2228 by 1652 pixels · central posterior field:
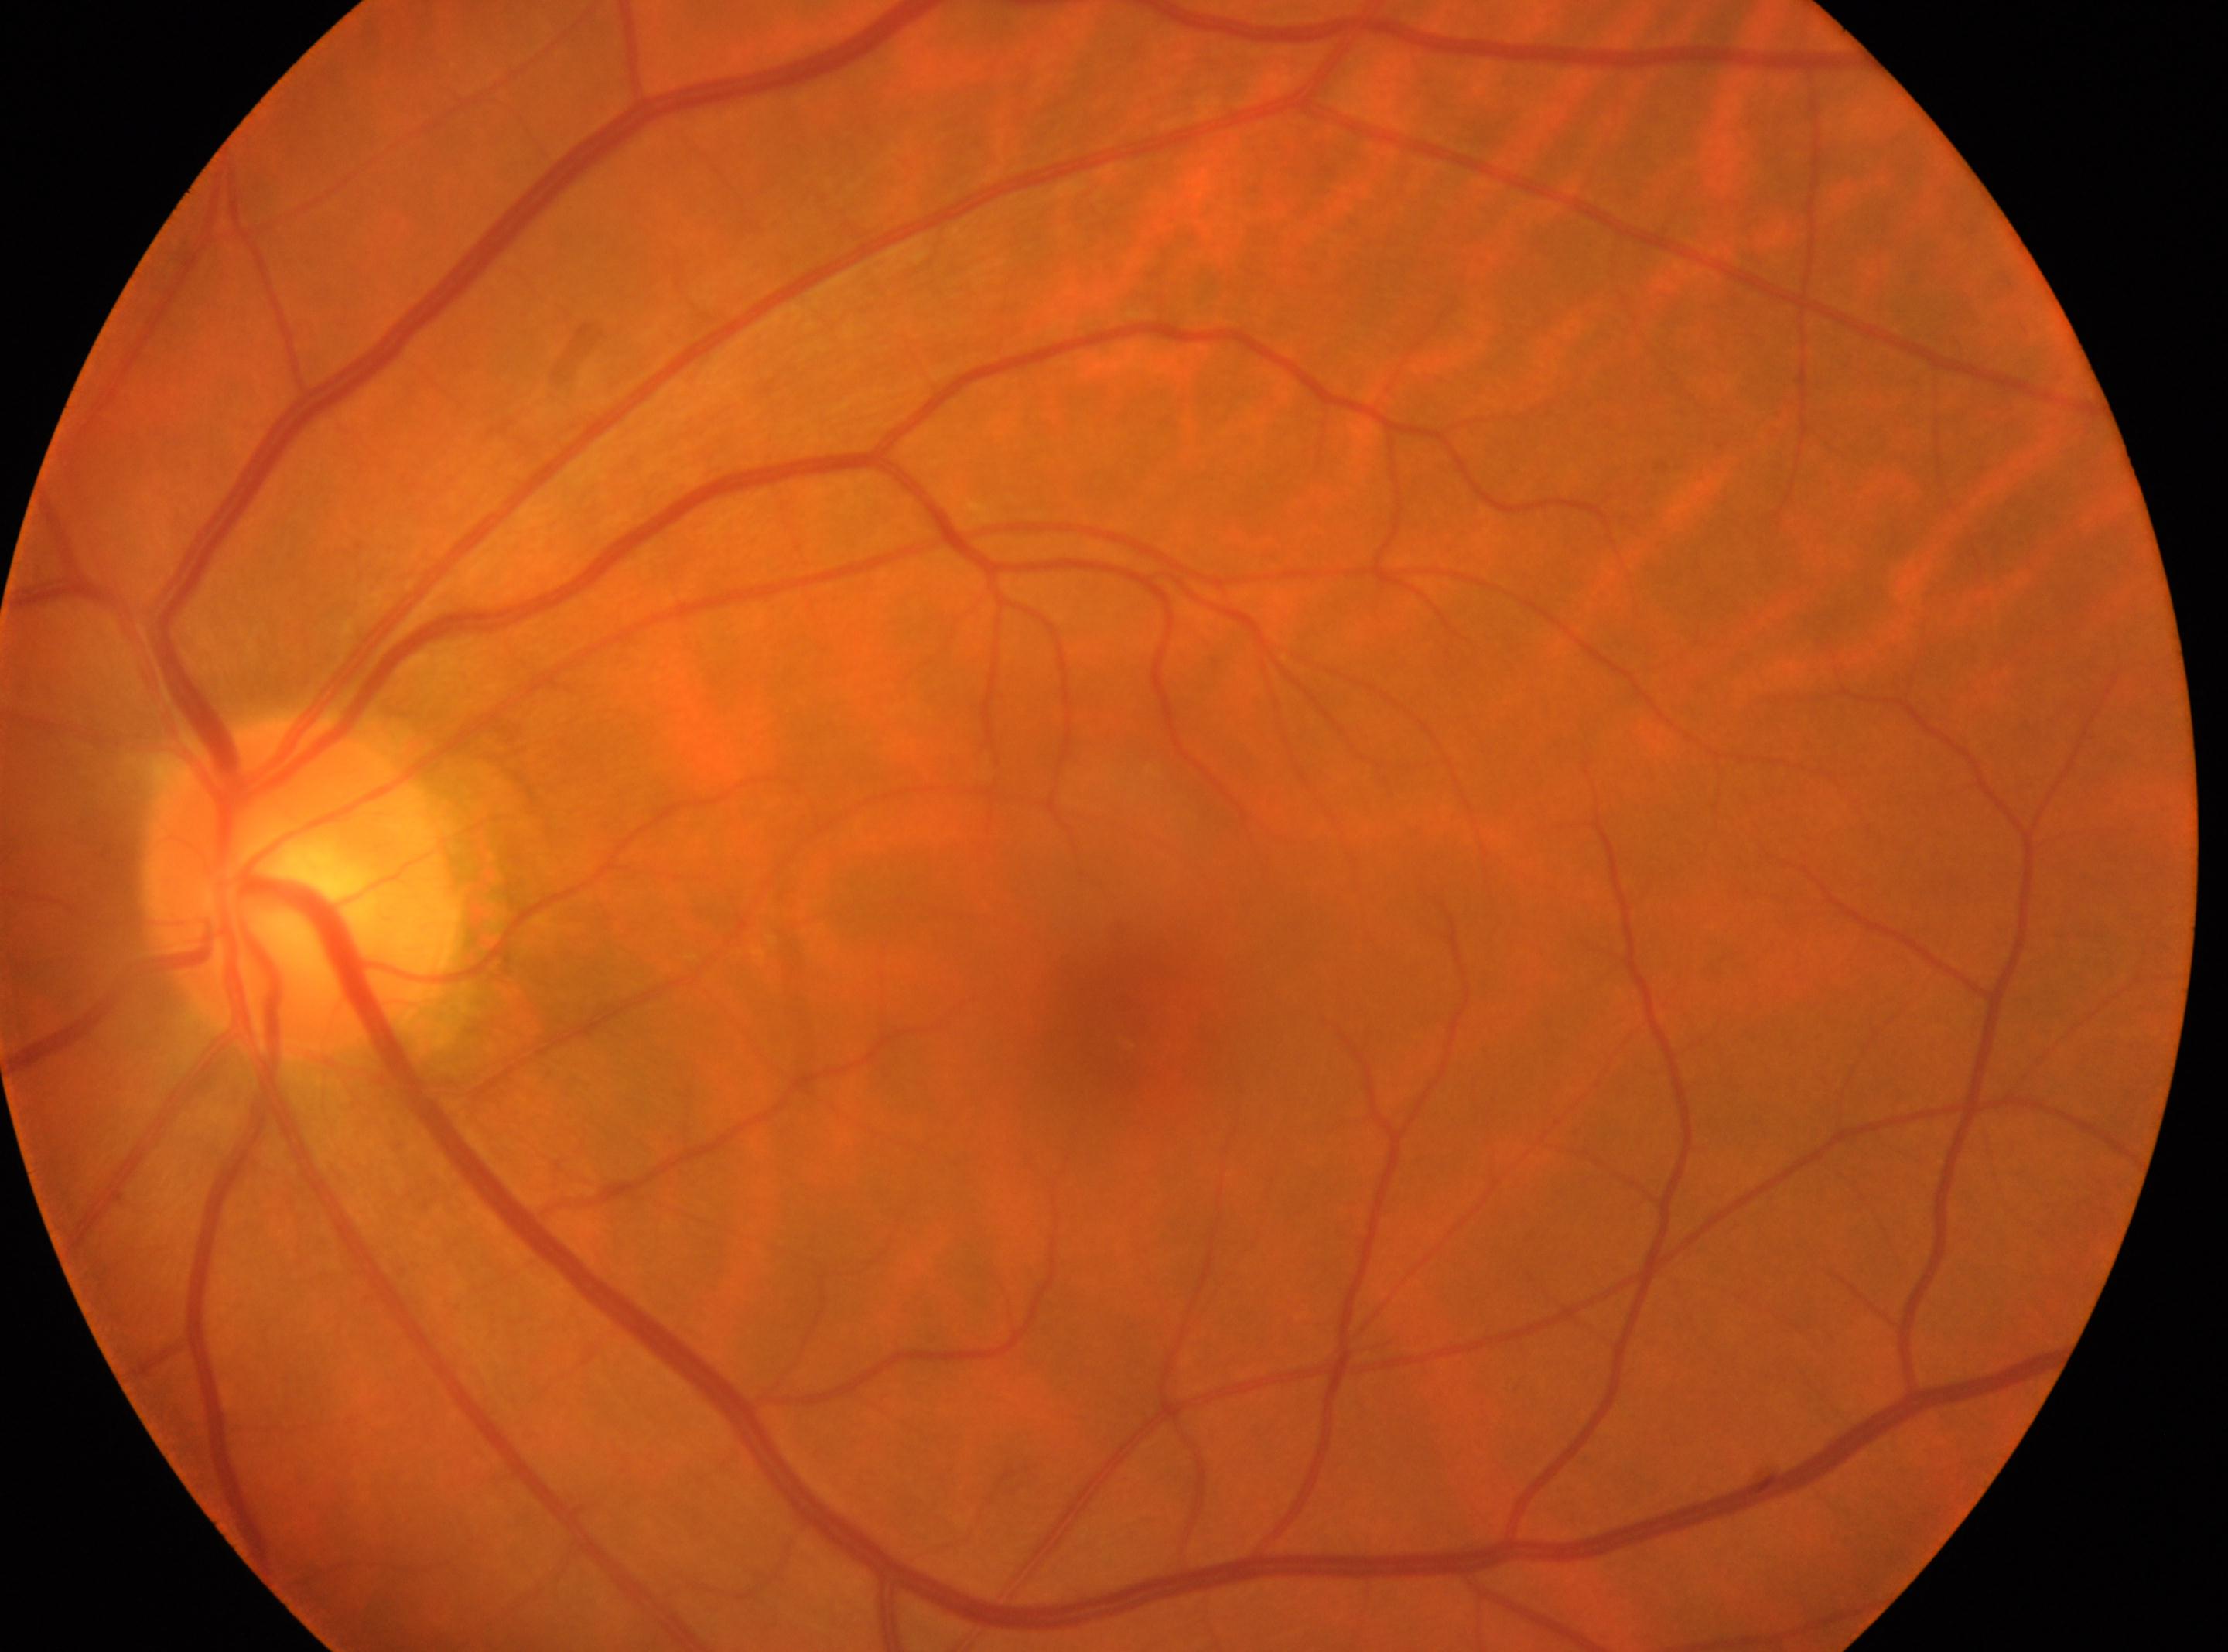

{
  "eye": "OS",
  "fovea": "(x=1129, y=1027)",
  "dr_grade": "0 (no apparent retinopathy)",
  "optic_disc": "(x=304, y=882)"
}